45-degree field of view.
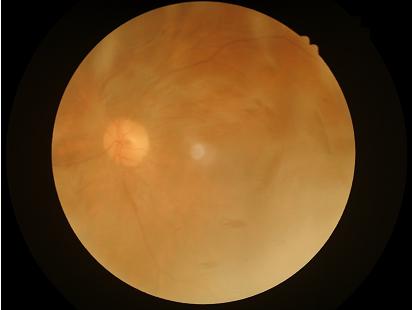 Overall image quality is poor.
Poor dynamic range.
Poor illumination with uneven exposure.
Reduced sharpness with visible blur.